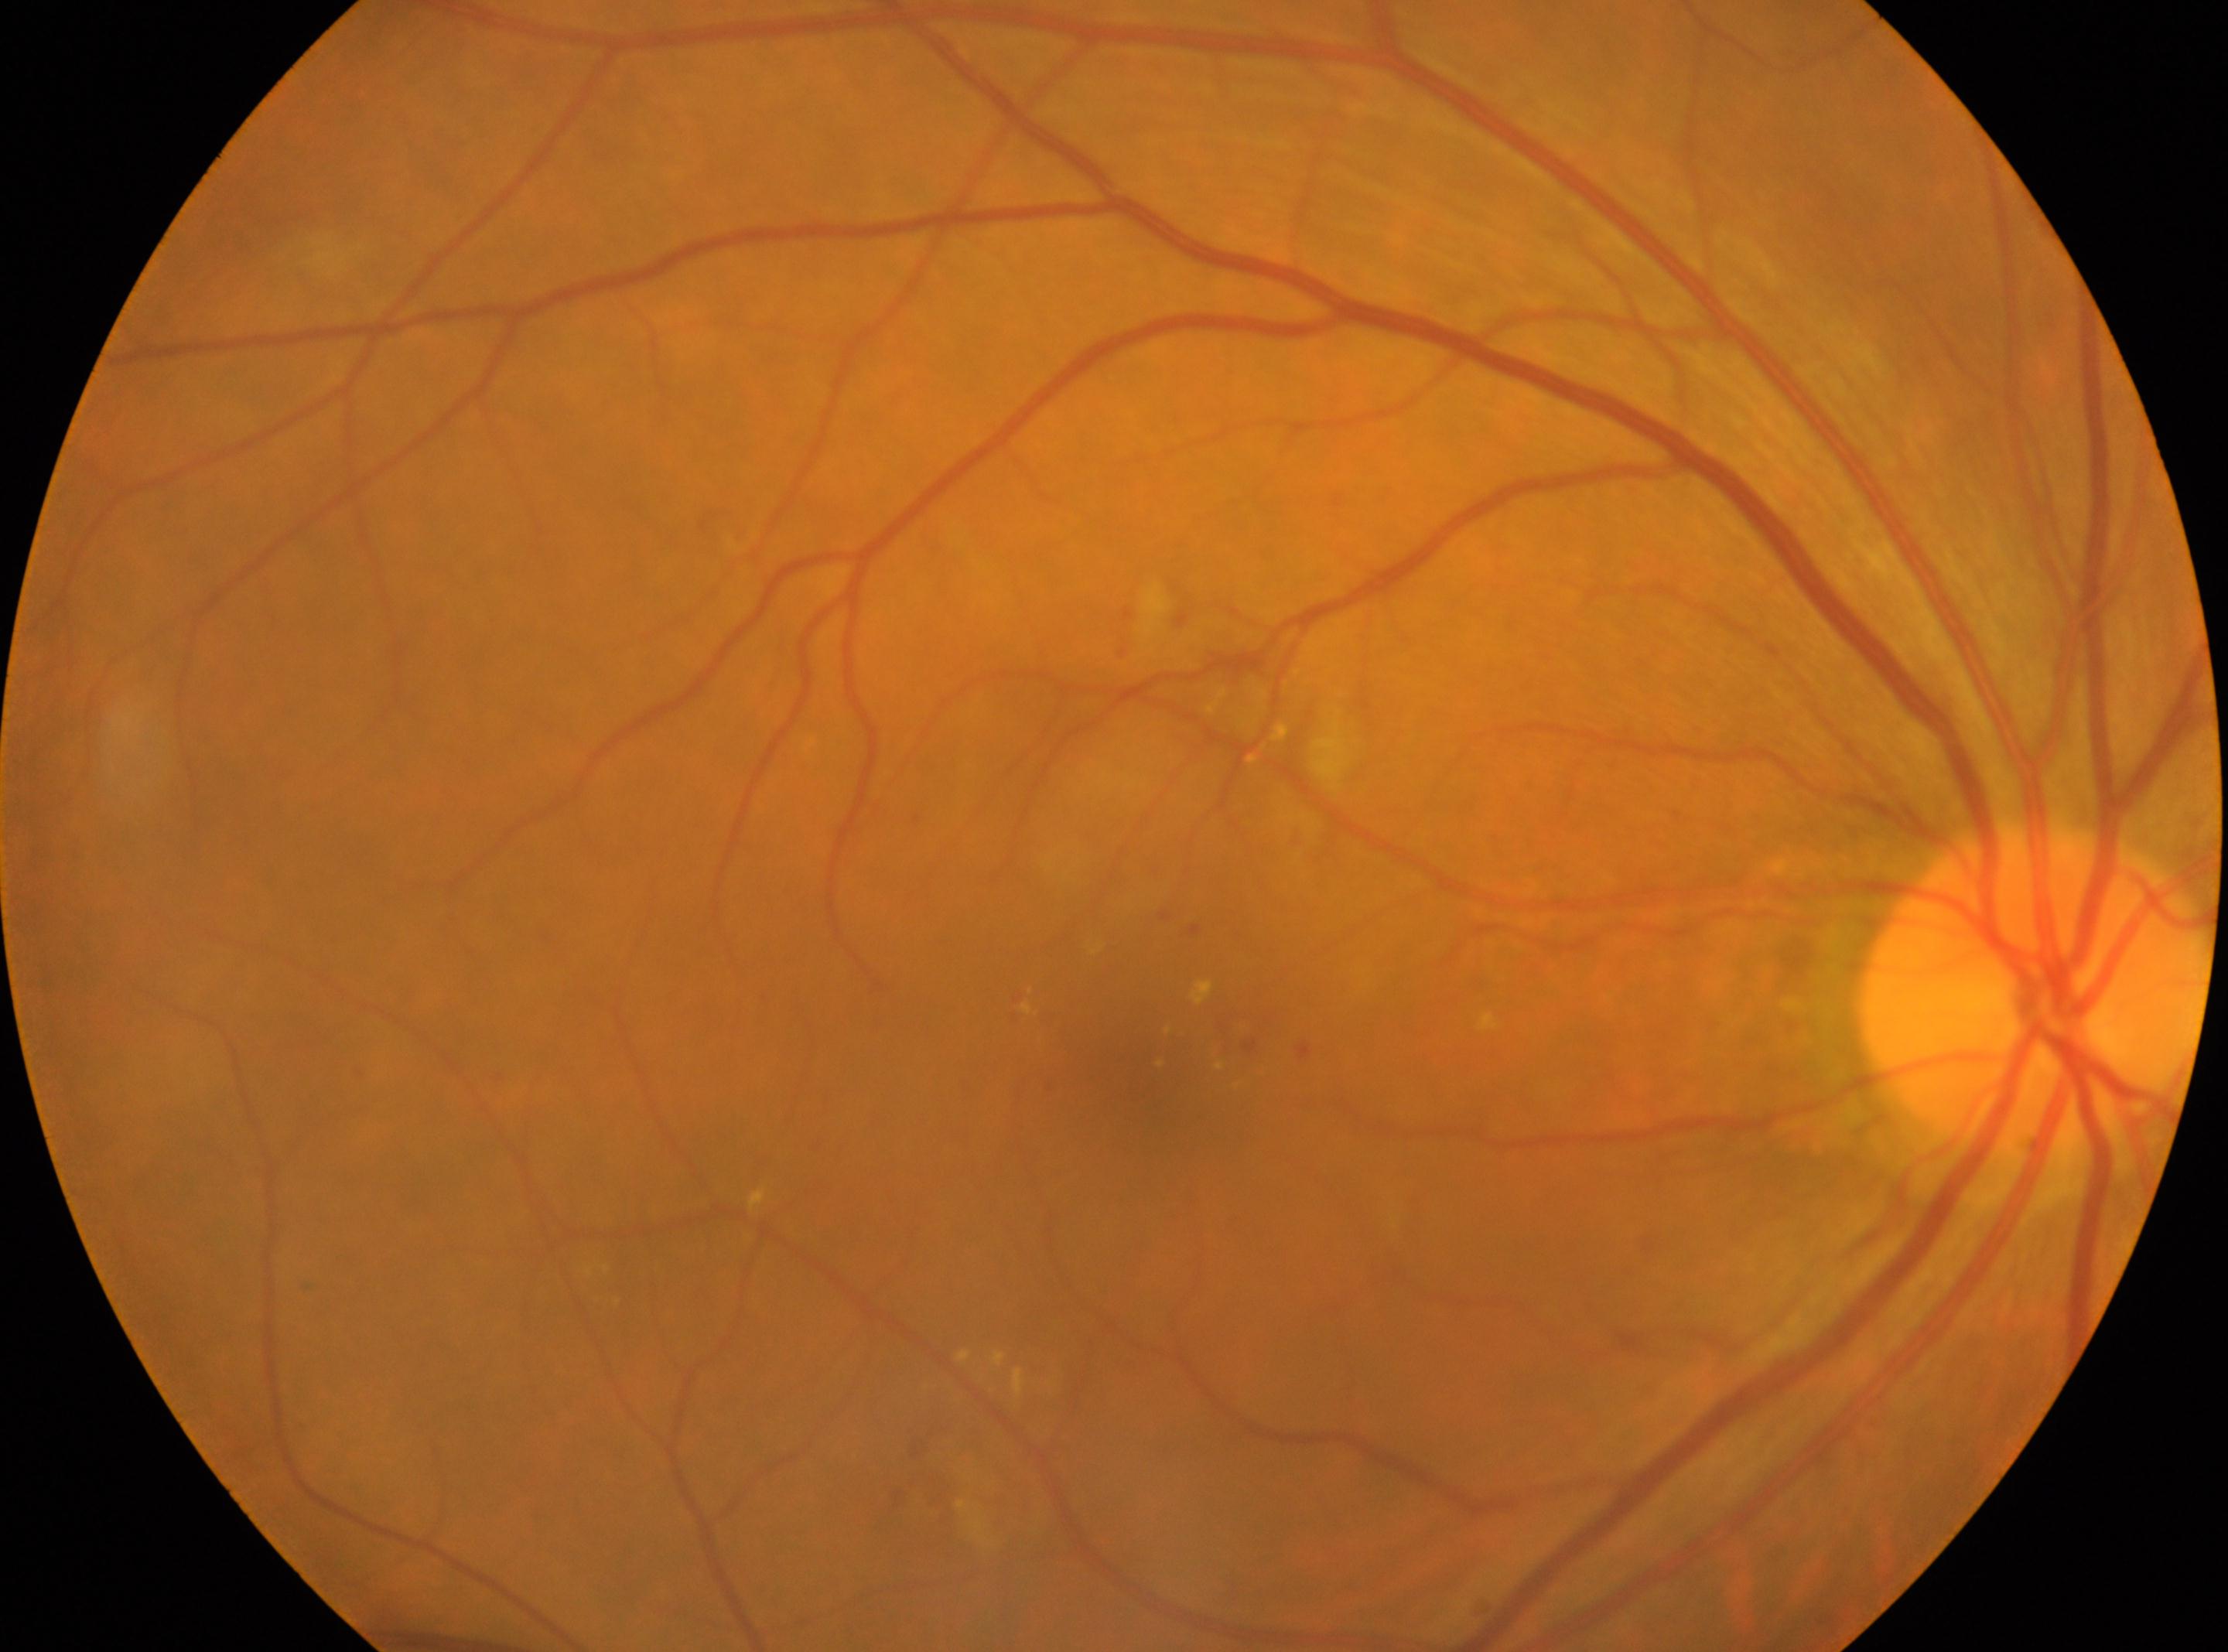
{
  "dr_grade": "2",
  "fovea": "x=1157, y=1050",
  "optic_disc": "x=2032, y=986",
  "eye": "the right eye"
}